Pediatric retinal photograph (wide-field); camera: Natus RetCam Envision (130° FOV); 1440x1080px
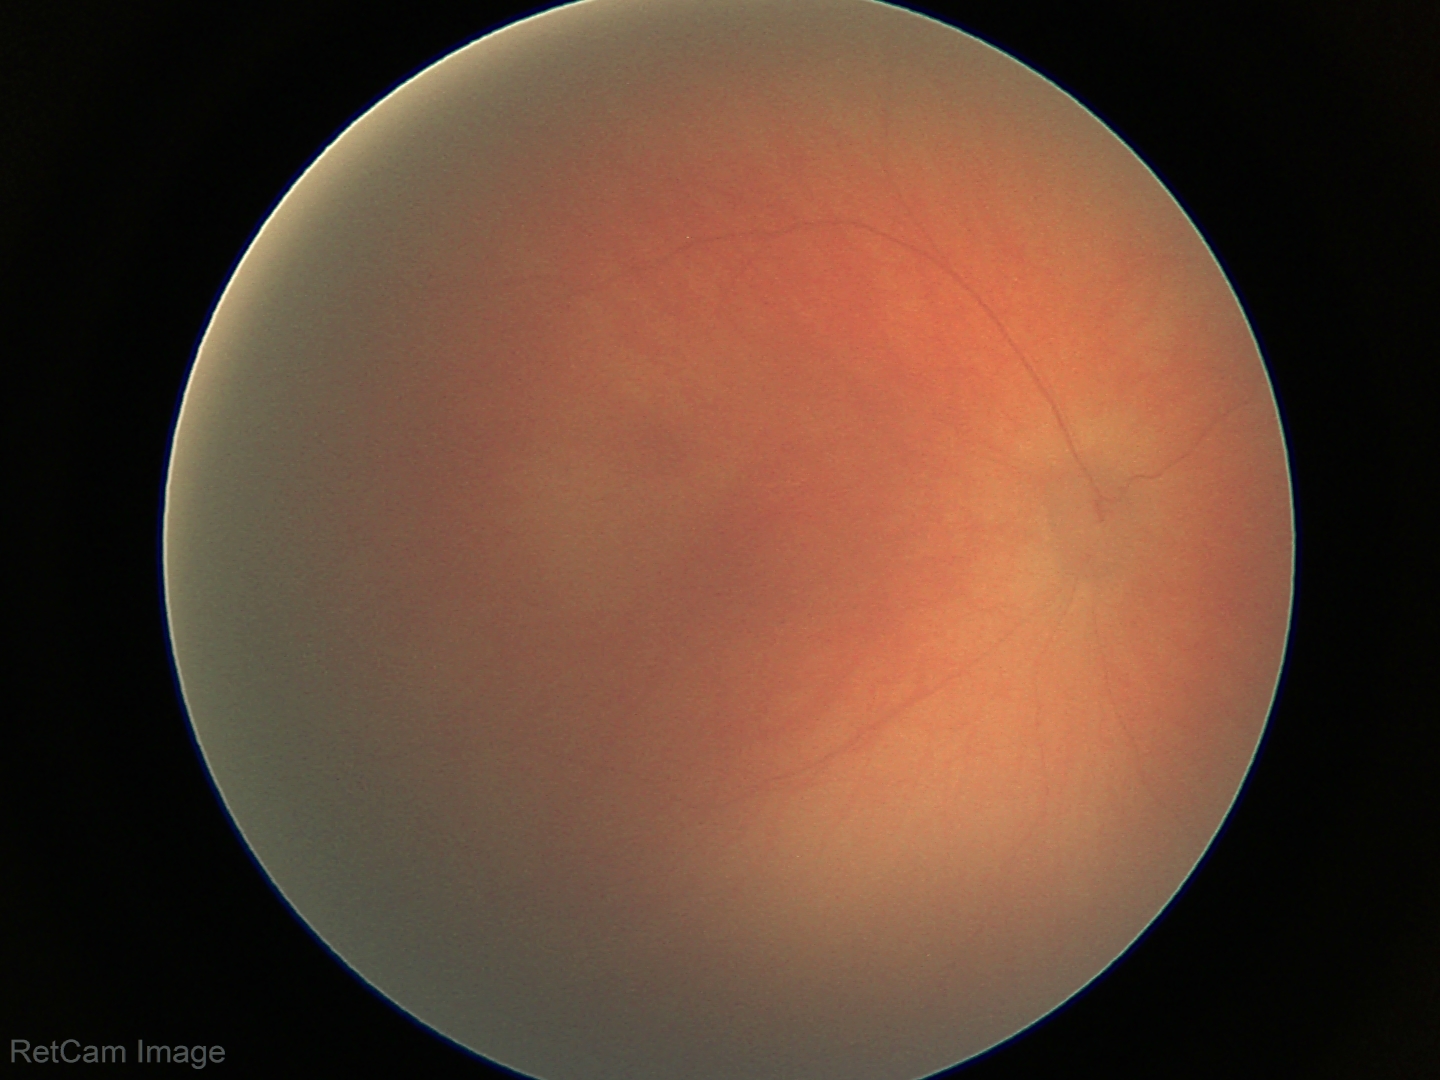
Physiological retinal appearance for postconceptual age.